200° field of view, image size 1924x1556, ultra-widefield fundus mosaic:
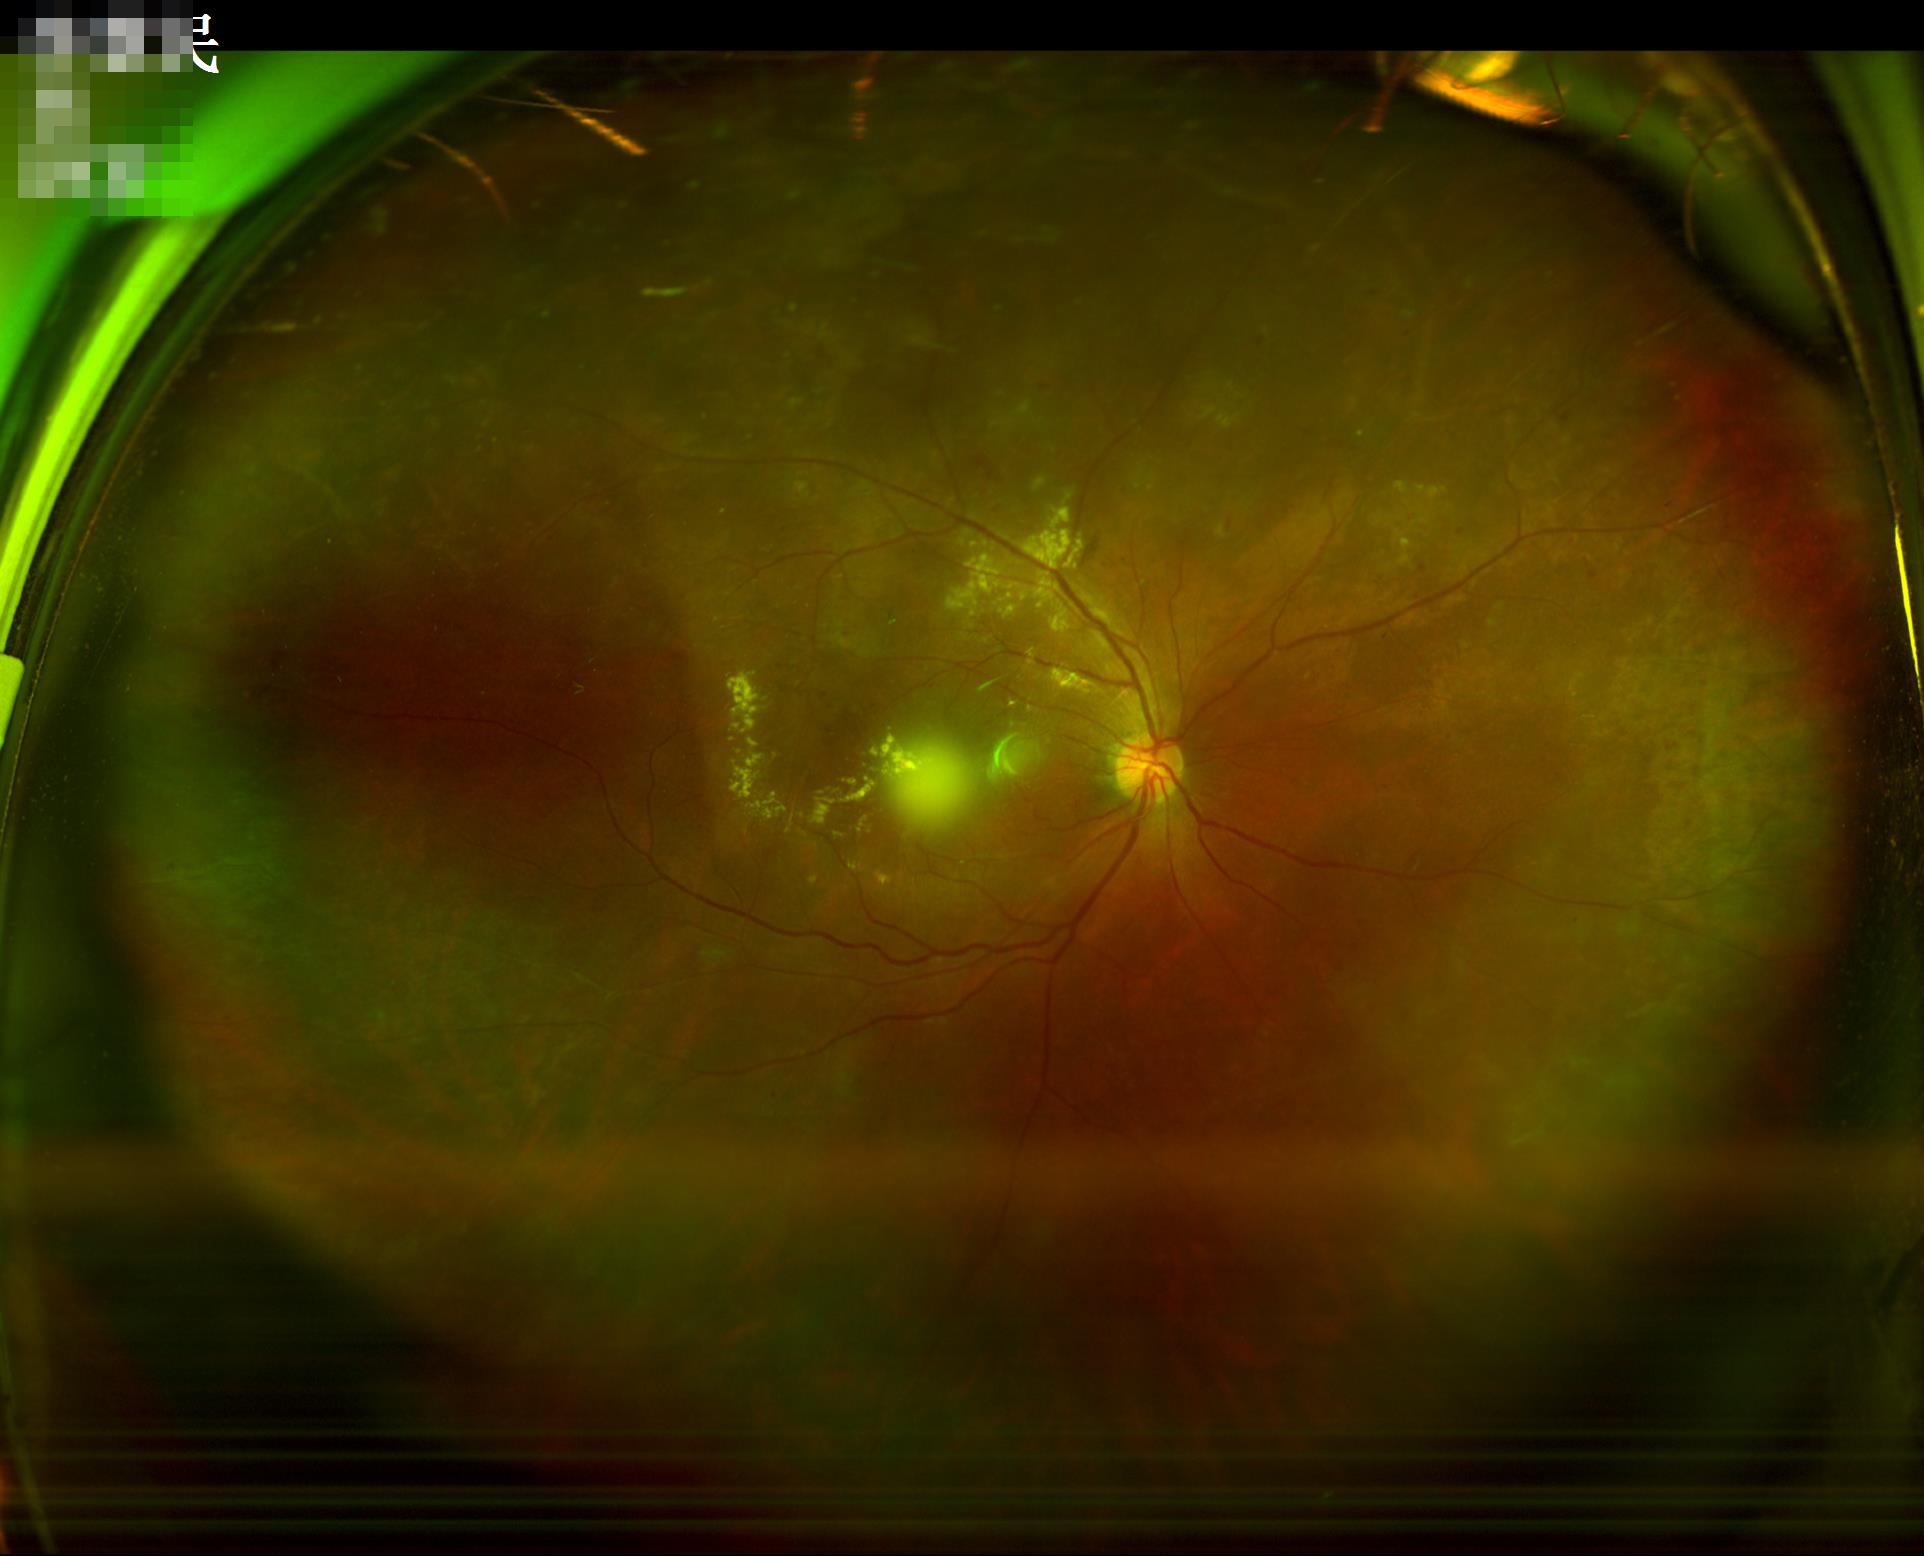

Image quality:
- sharpness: reduced sharpness with visible blur
- overall: good, gradable
- contrast: vessels and details readily distinguishable
- illumination/color: good illumination and color balance